Graded on the modified Davis scale; 848 x 848 pixels.
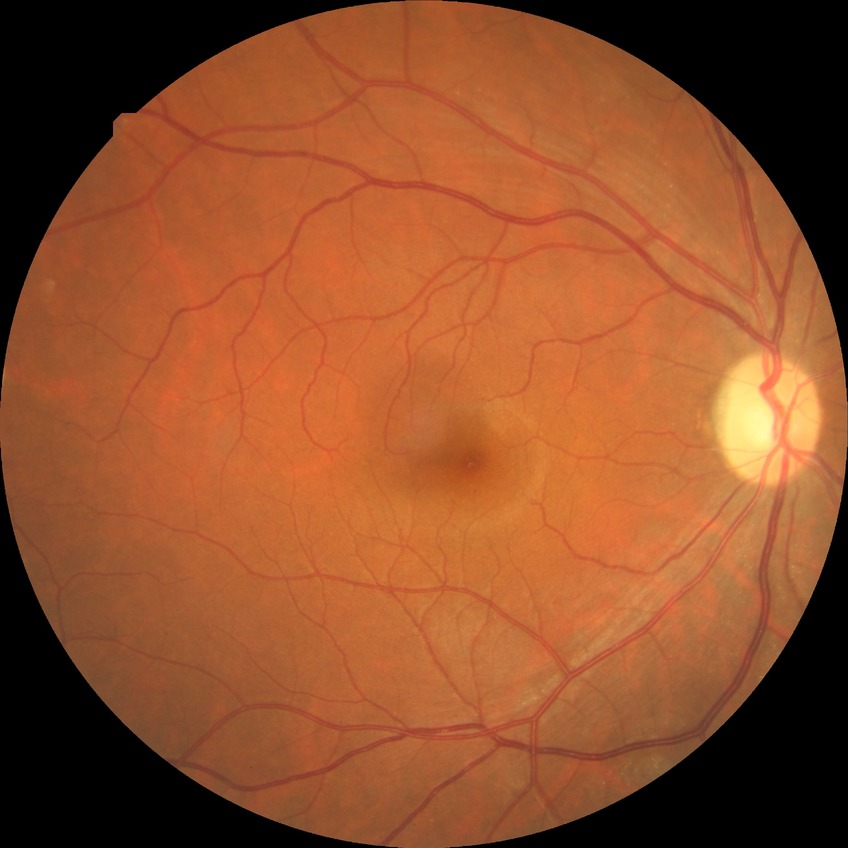

Annotations:
– DR impression: no signs of DR
– DR stage: NDR